Acquired with a NIDEK AFC-230. Diabetic retinopathy graded by the modified Davis classification. Image size 848x848. 45° FOV
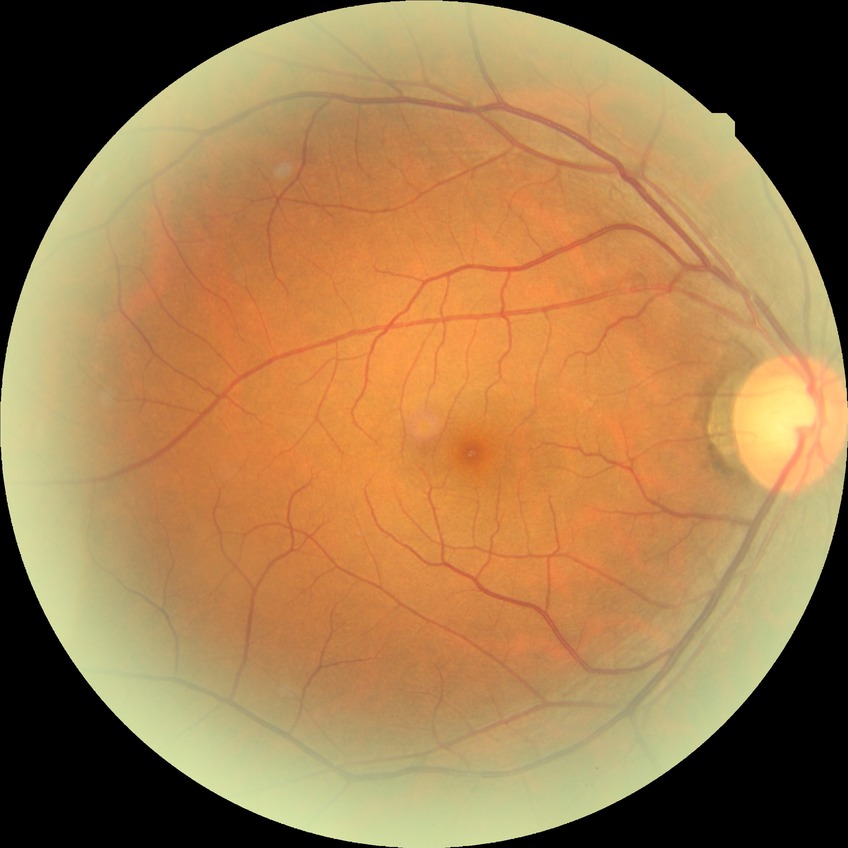
  davis_grade: no diabetic retinopathy